Color fundus image. Nonmydriatic. NIDEK AFC-230 fundus camera — 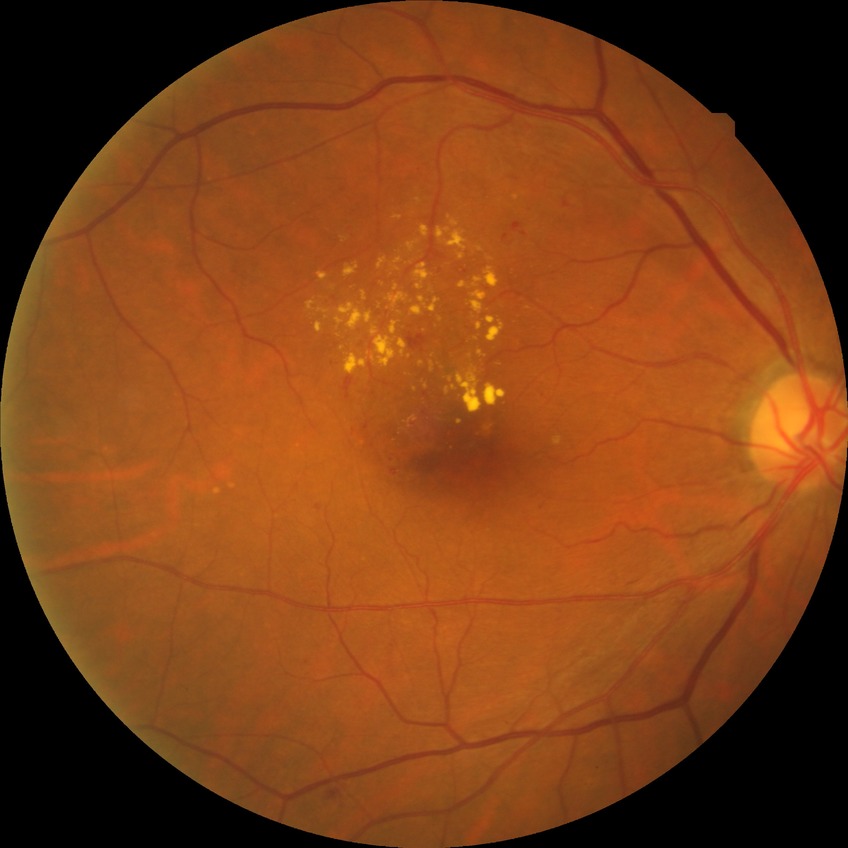

Diabetic retinopathy (DR) is SDR (simple diabetic retinopathy).